Image size 2352x1568. 45-degree field of view: 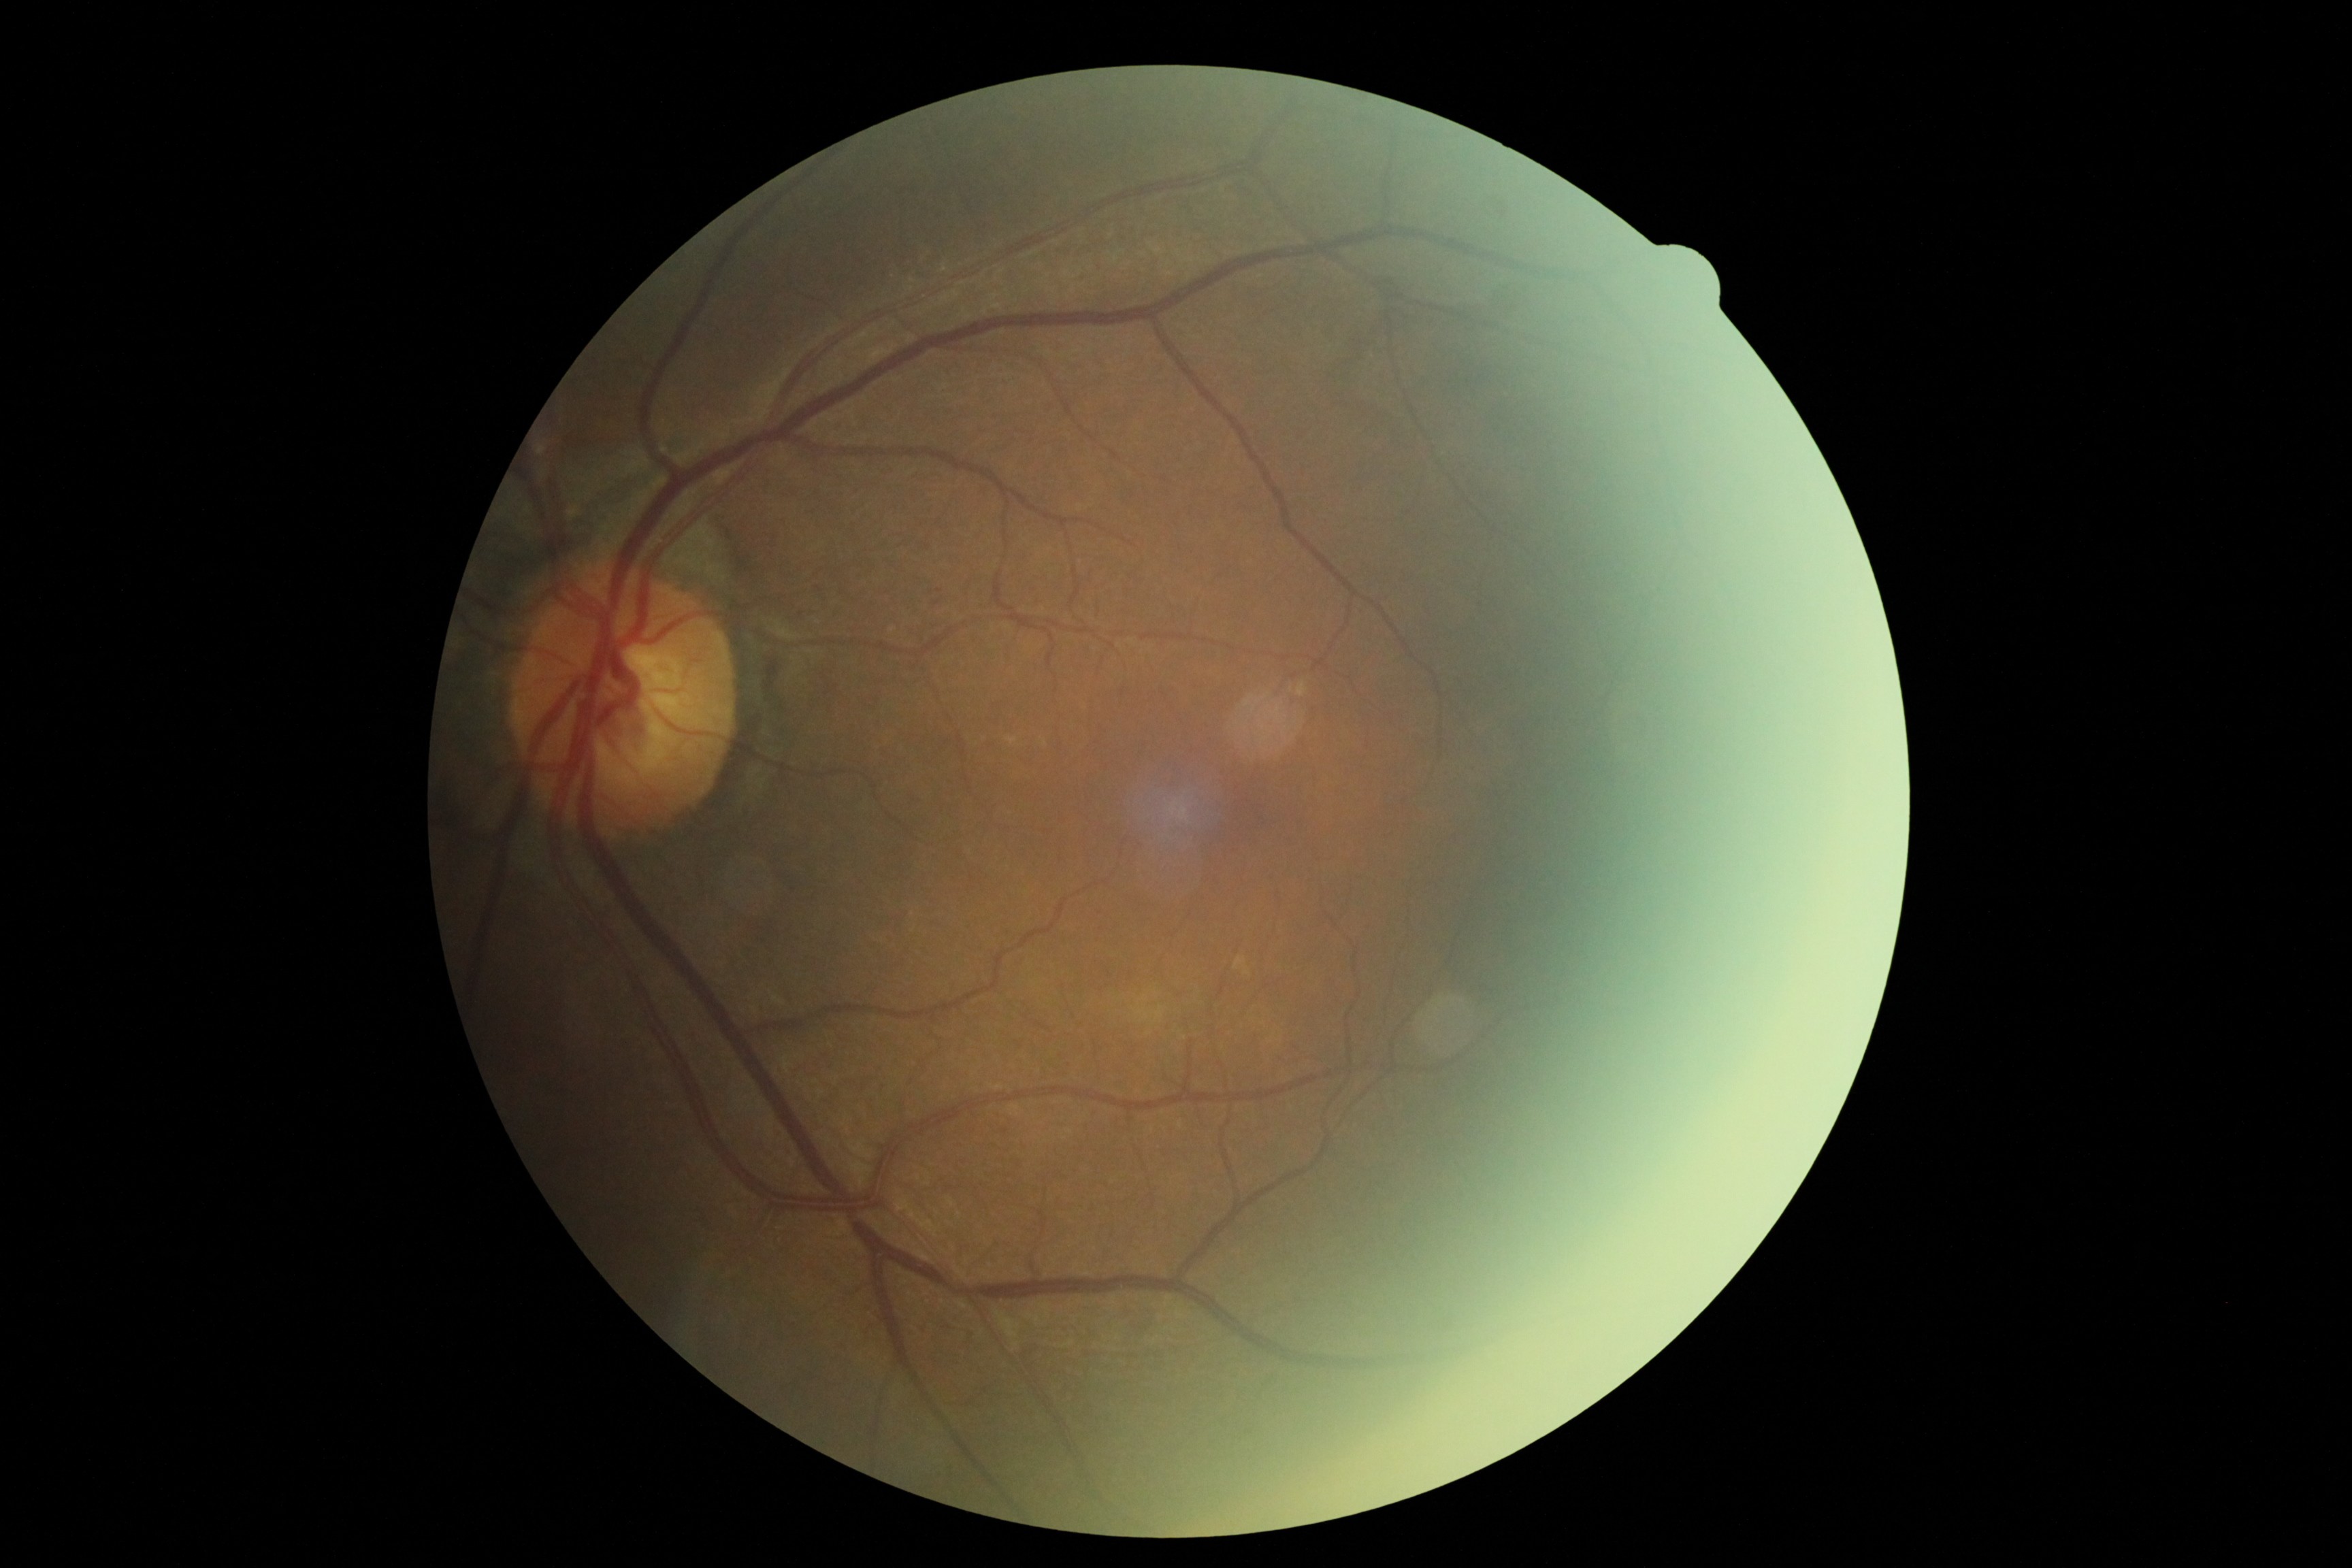 DR: 1.